1924x1556; 200° field of view; UWF retinal mosaic: 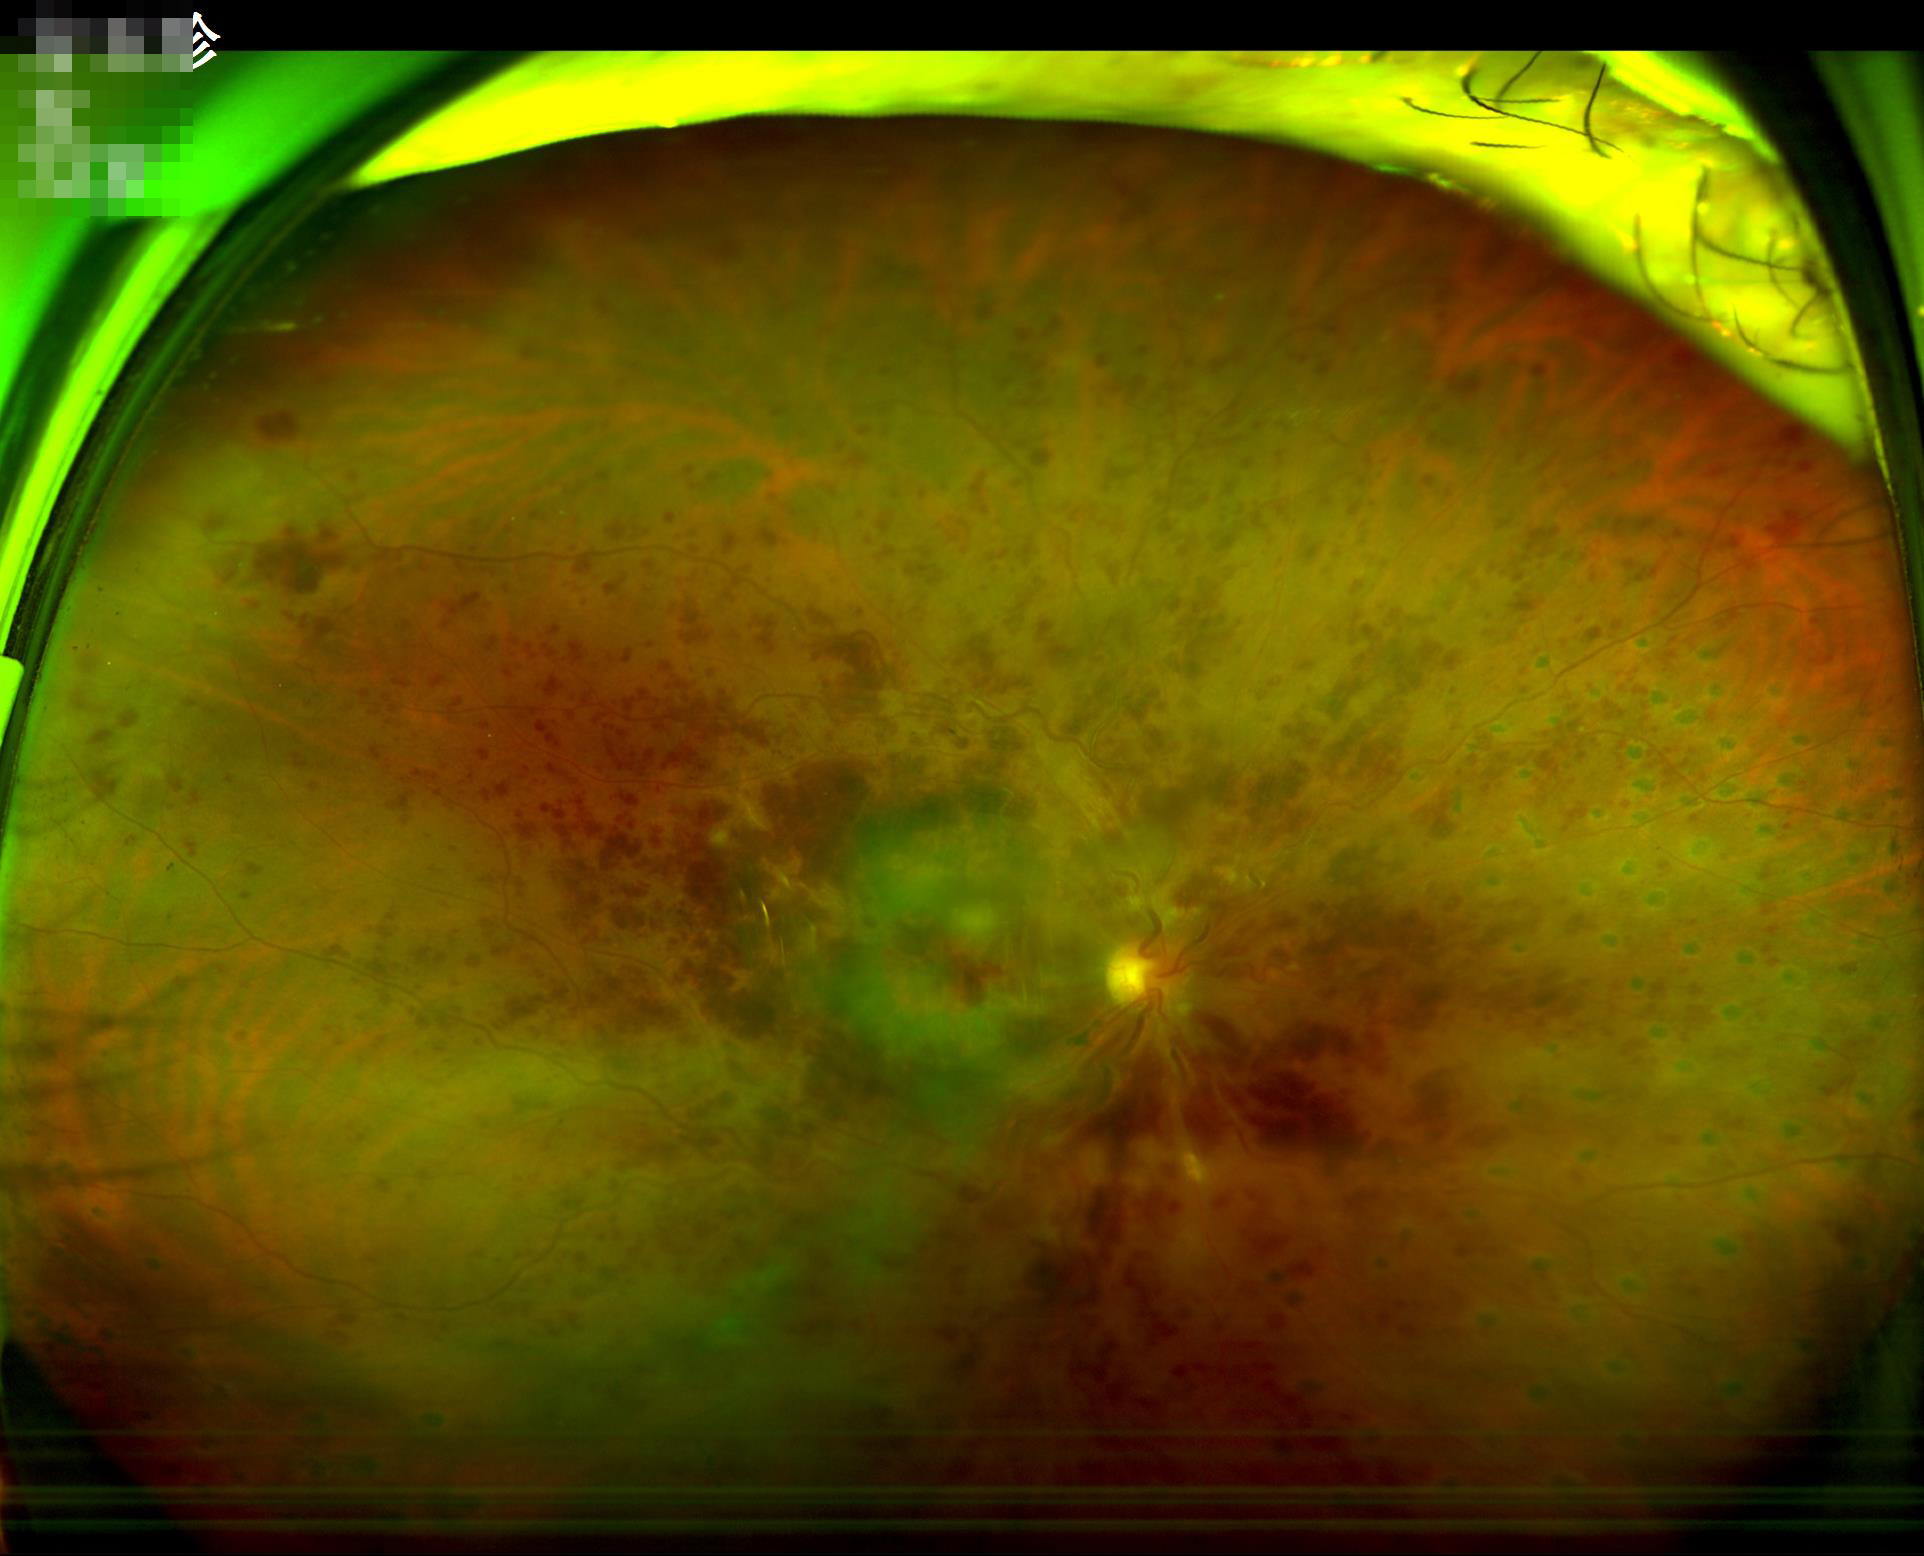
{
  "contrast": "reduced",
  "overall_quality": "suboptimal",
  "illumination": "adequate",
  "clarity": "blurry"
}